2048x1536 — 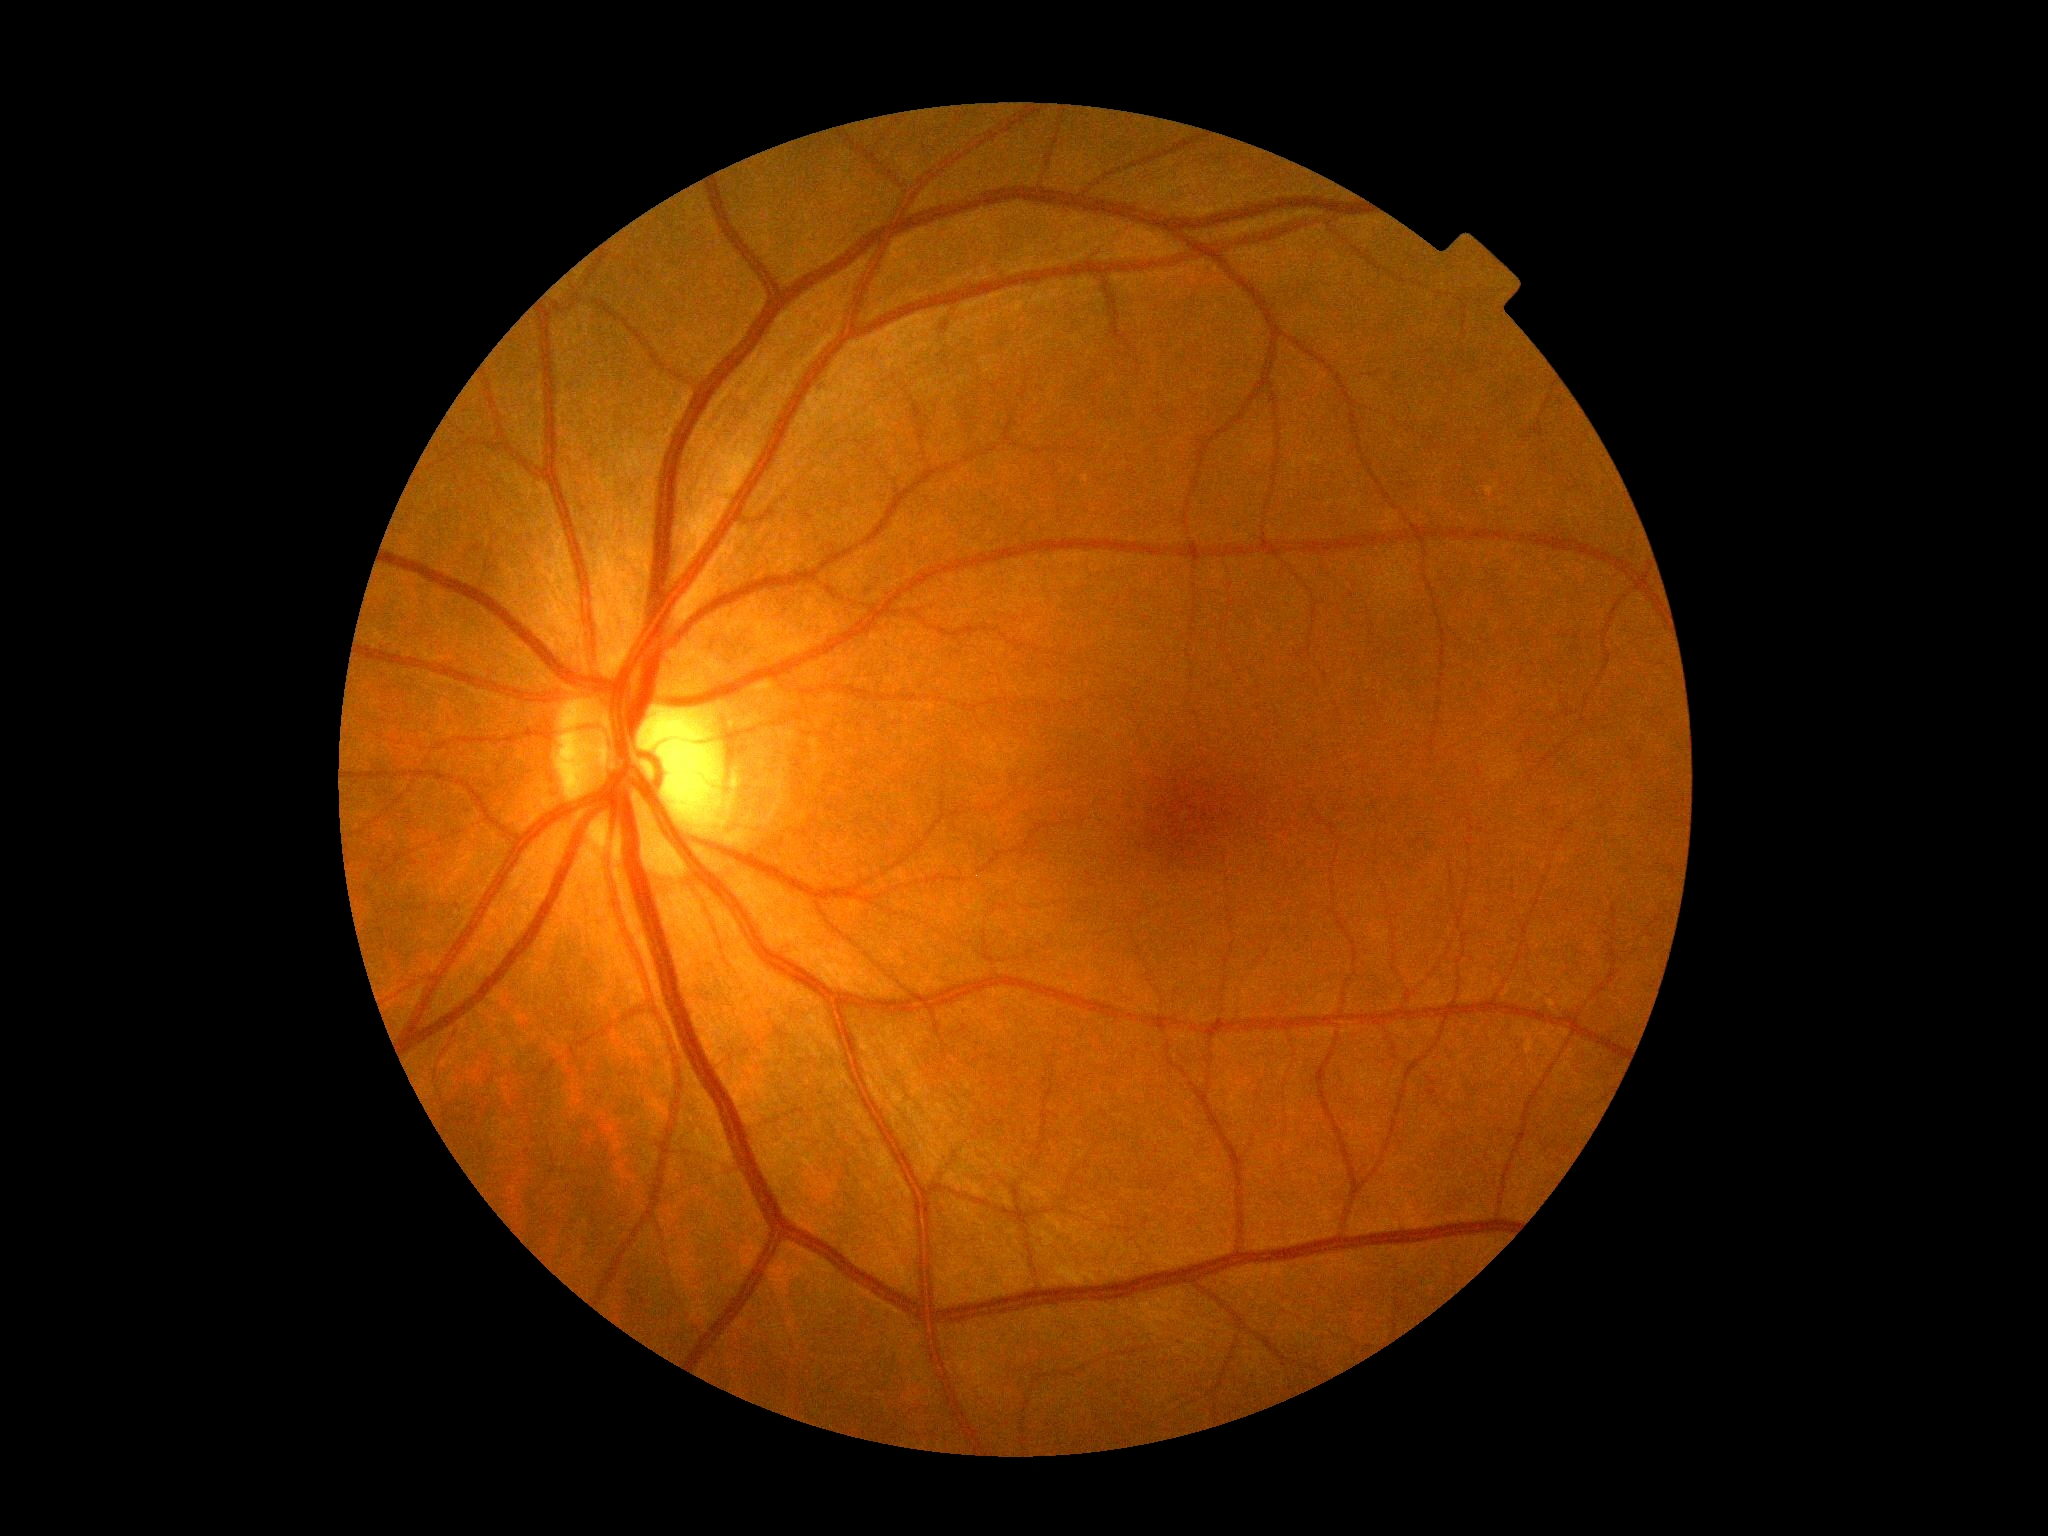
No diabetic retinal disease findings. DR severity: 0/4.